CFP
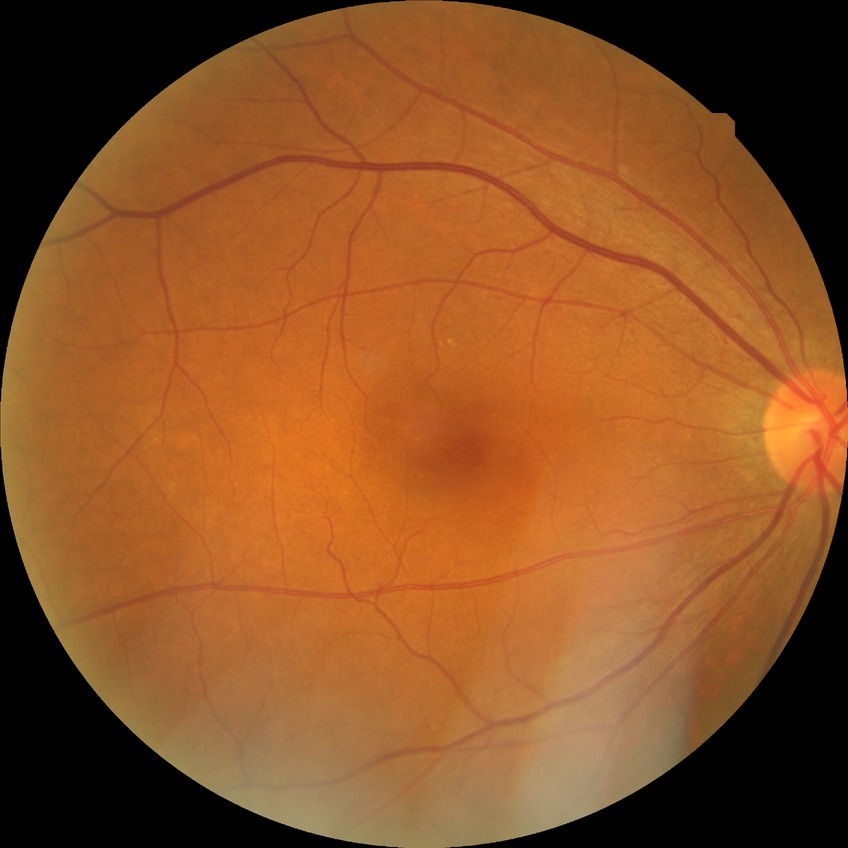
Diabetic retinopathy (DR) is no diabetic retinopathy (NDR).